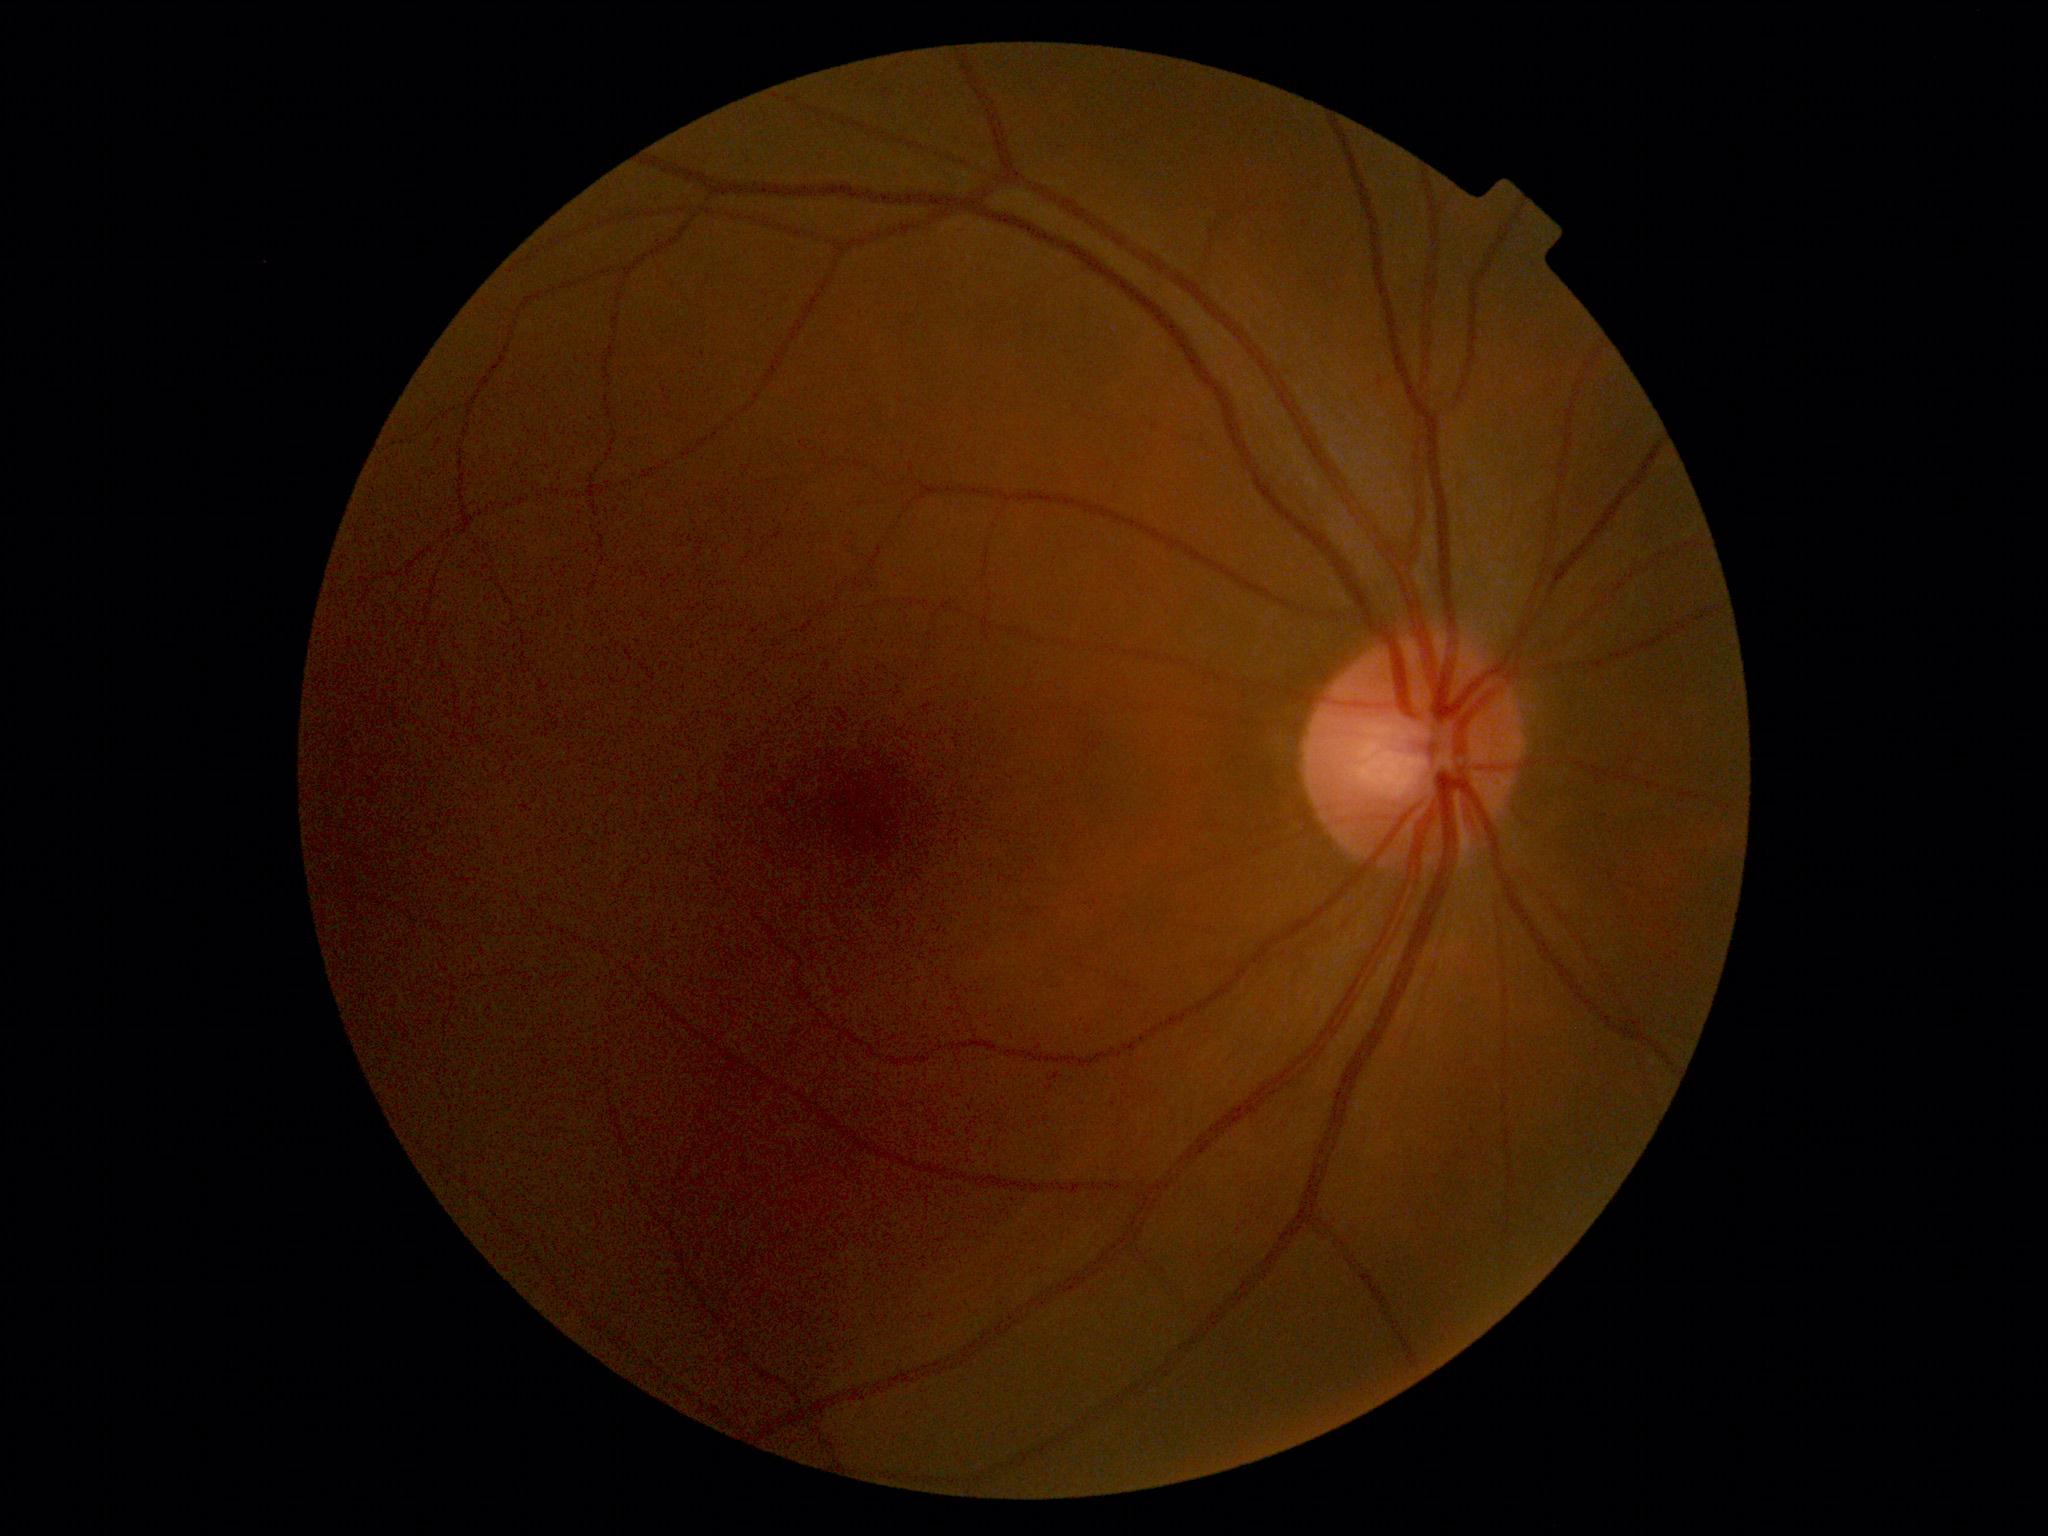 Diabetic retinopathy (DR) is grade 0 (no apparent retinopathy).